Optic disc-centered crop from a color fundus photograph, captured with pupil dilation: 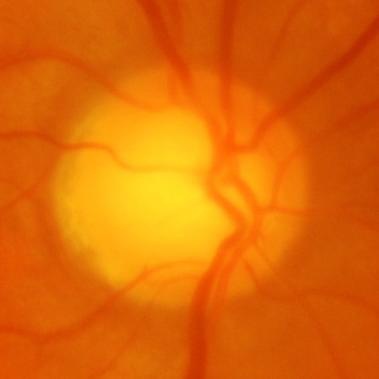 Showing glaucoma.